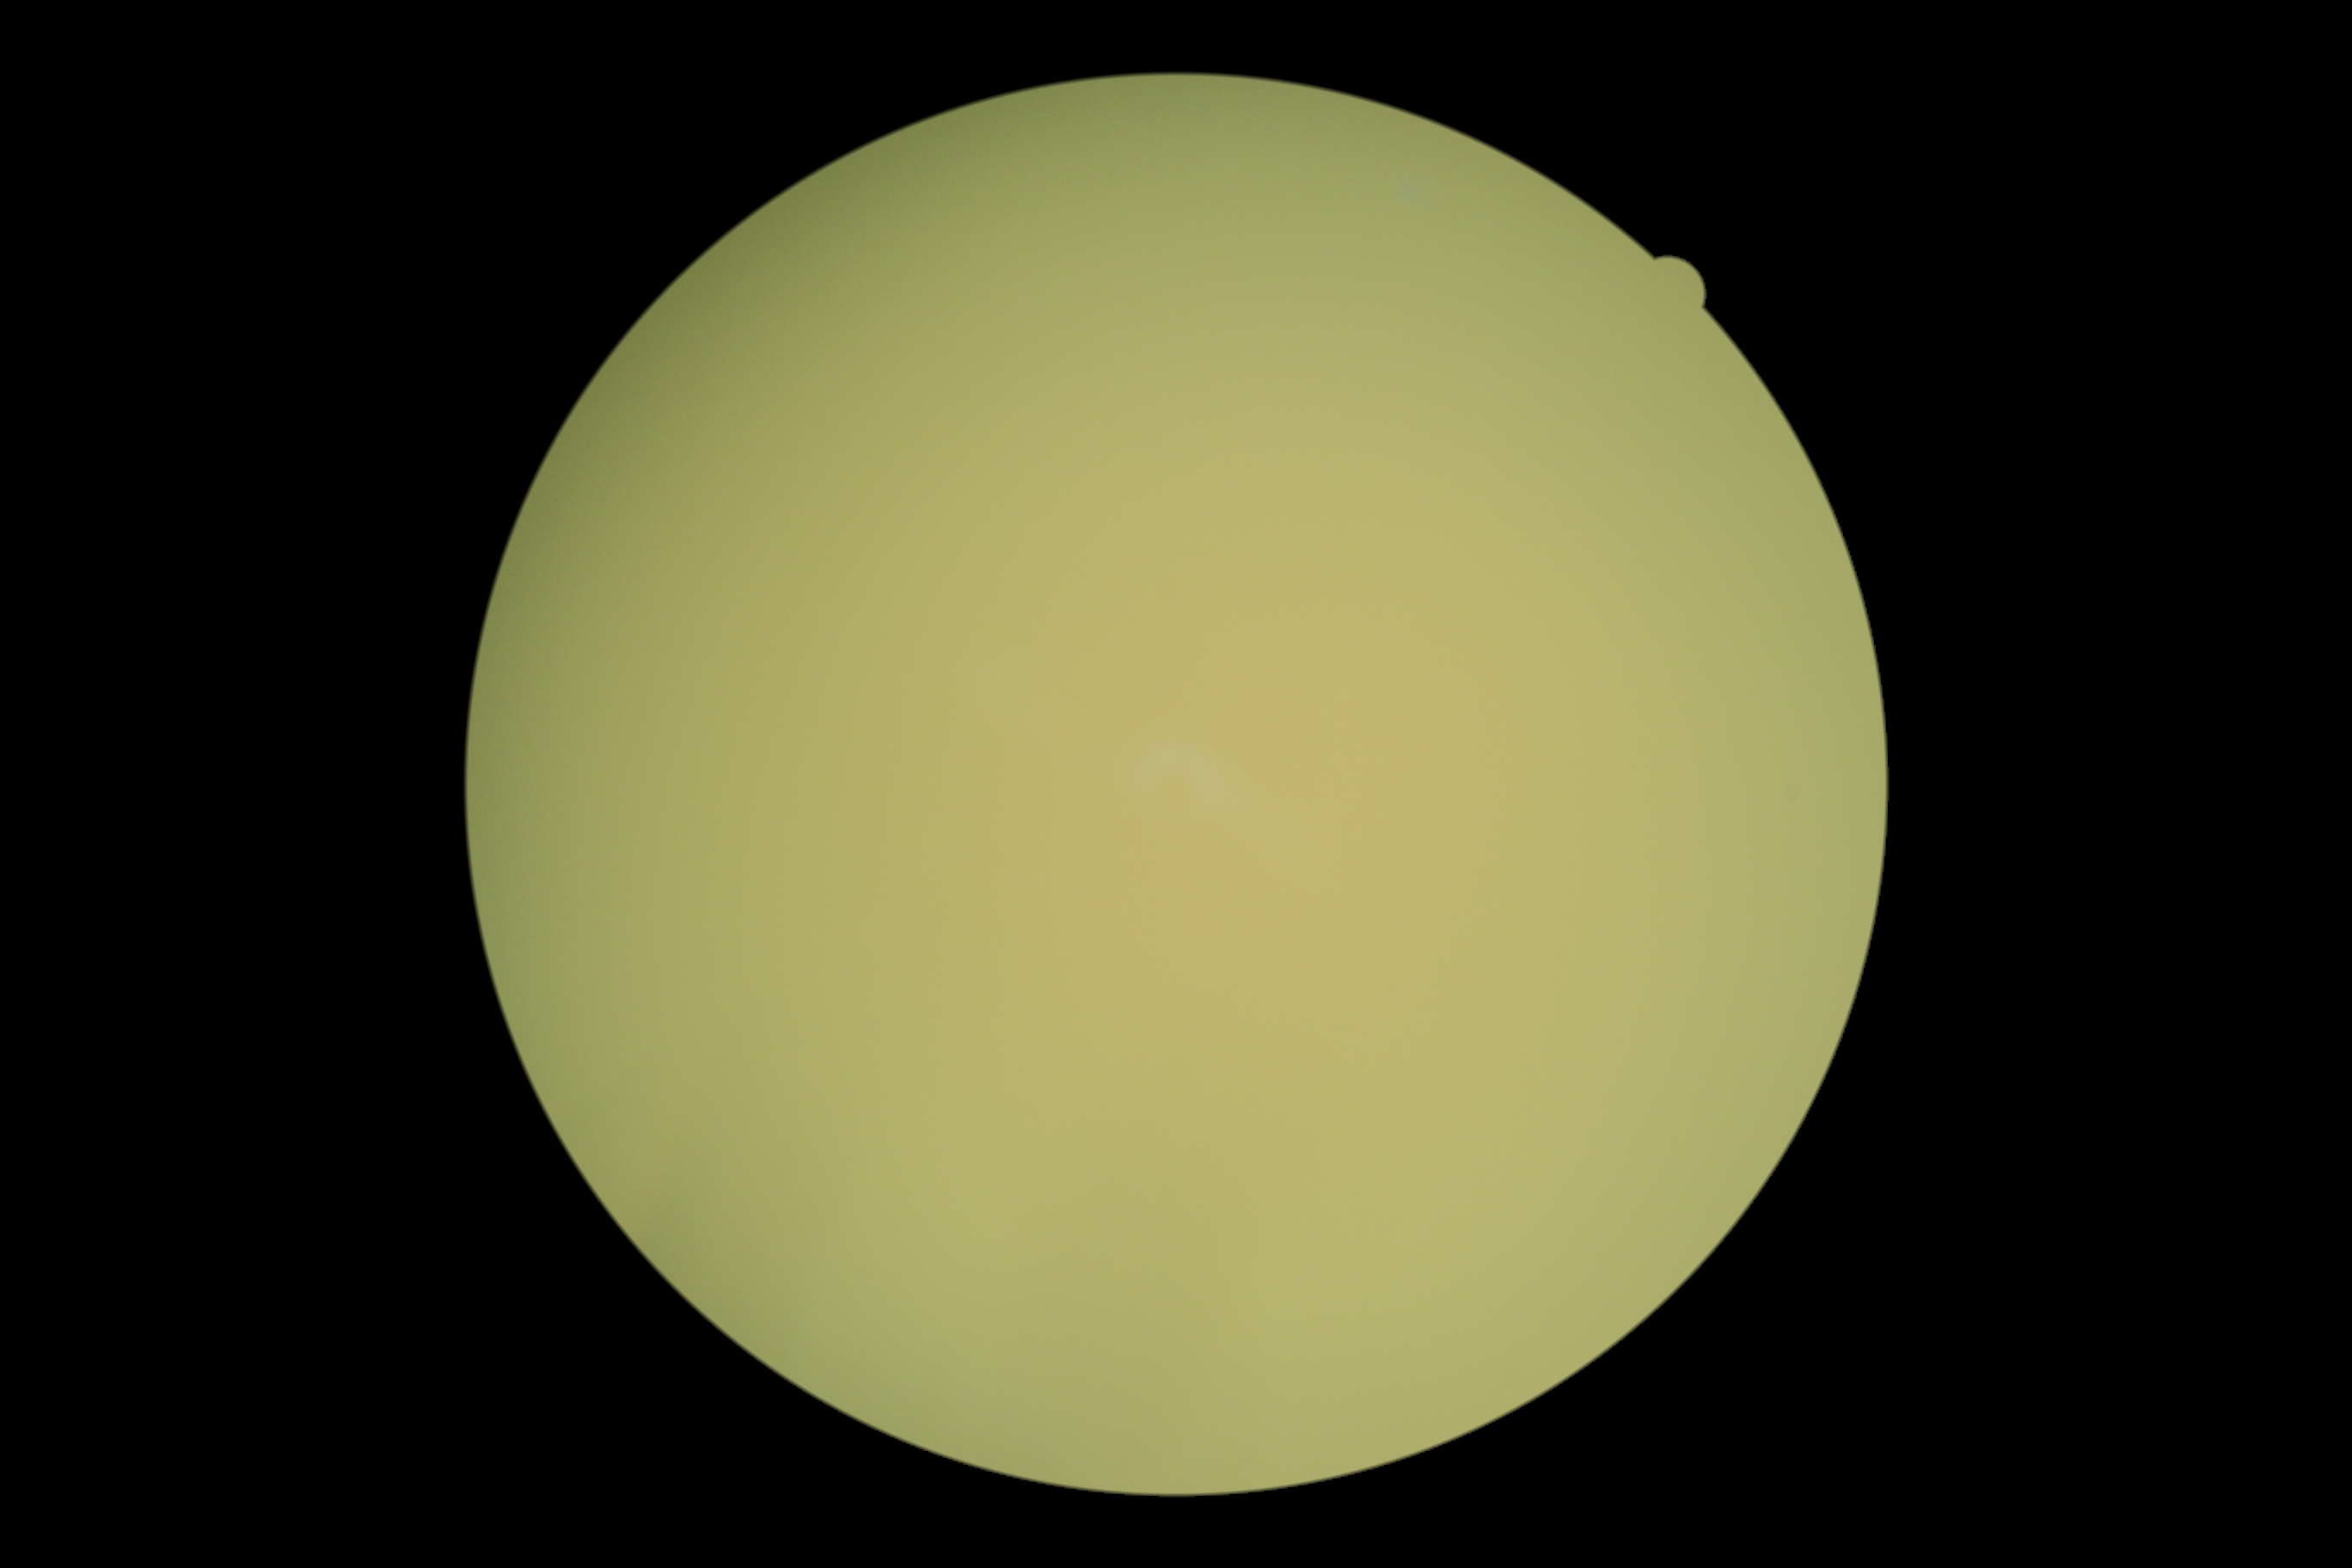
dr_grade: ungradable due to poor image quality